Davis DR grading · 848x848 — 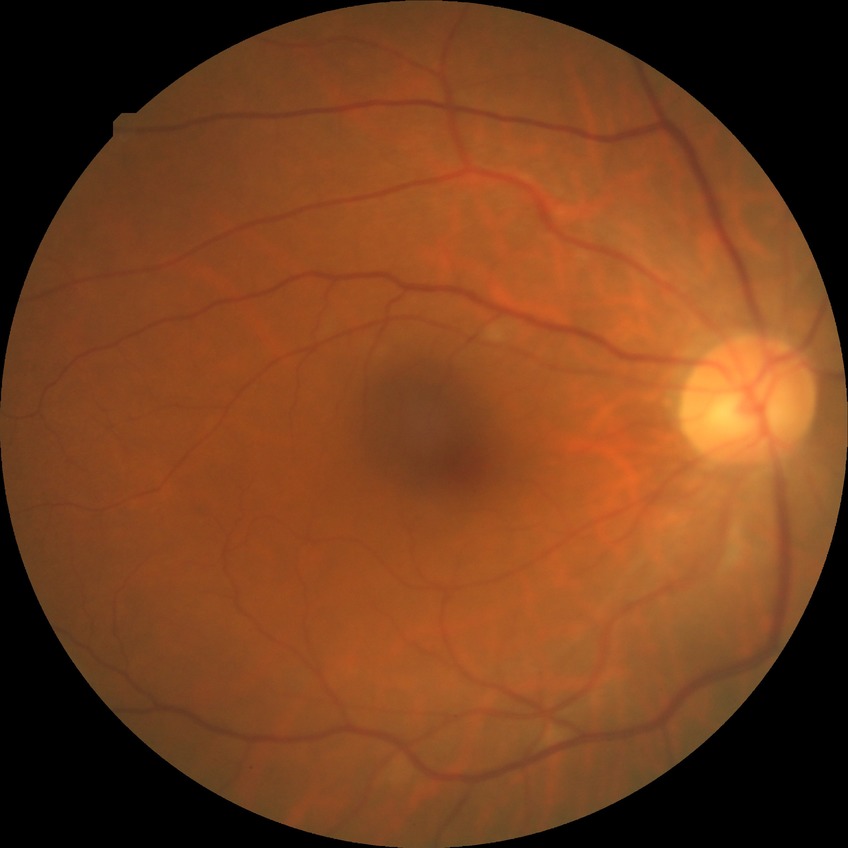

Diabetic retinopathy (DR): NDR (no diabetic retinopathy).